Wide-field fundus photograph of an infant.
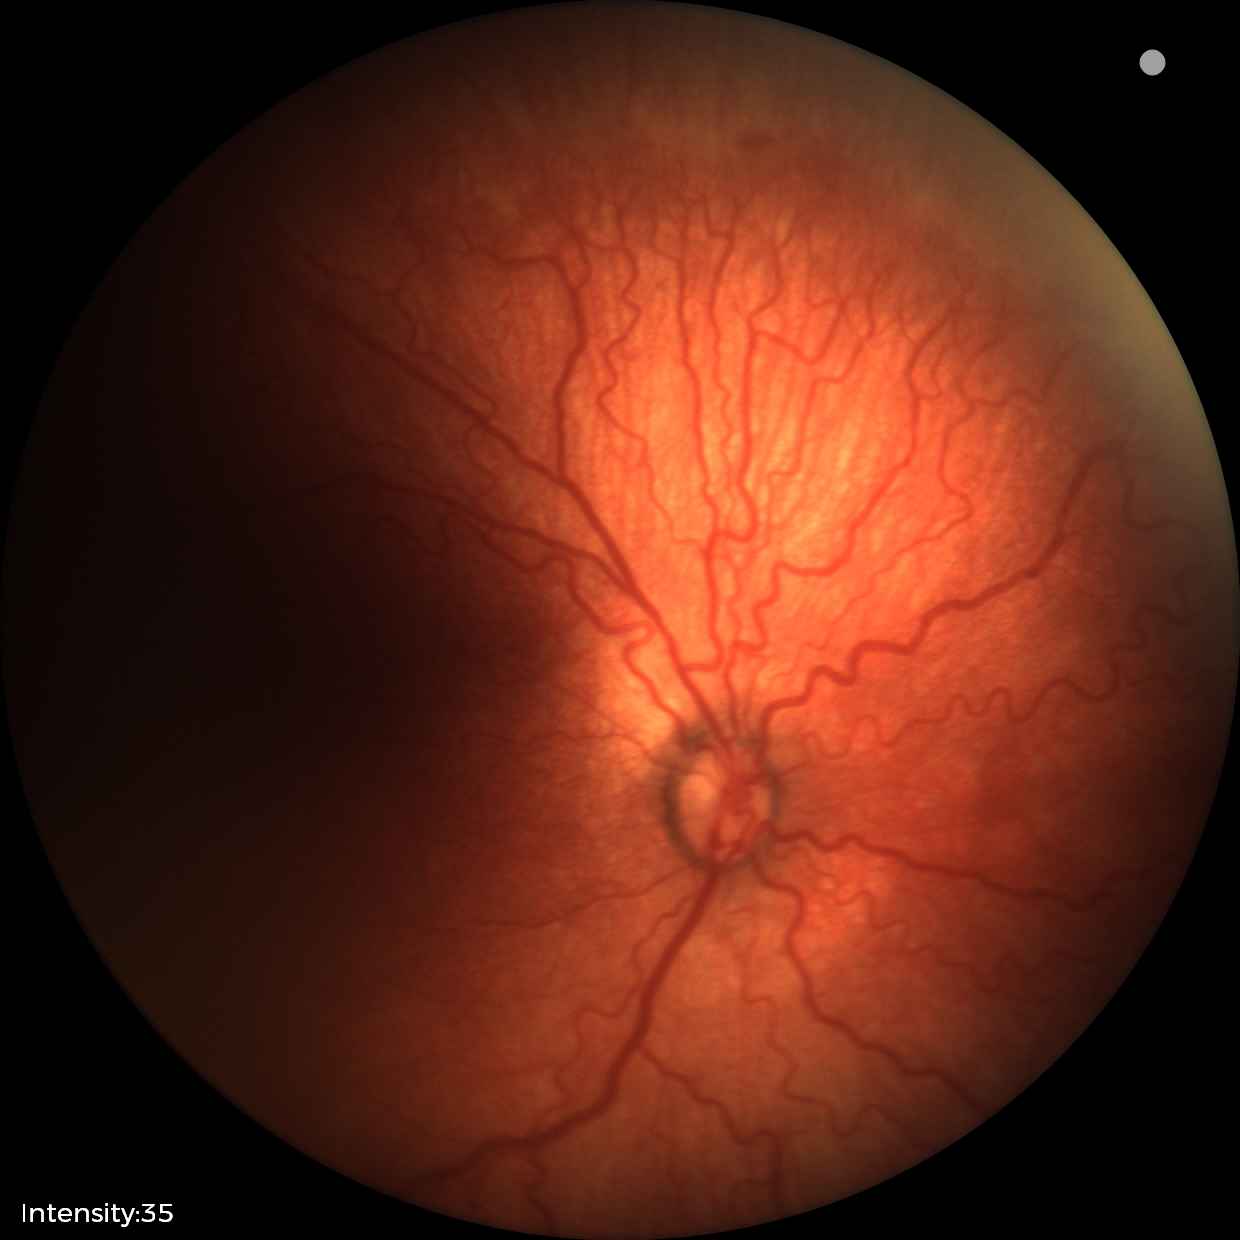

Examination diagnosed as retinopathy of prematurity (ROP) stage 2.
With plus disease.